Optic disc region crop.
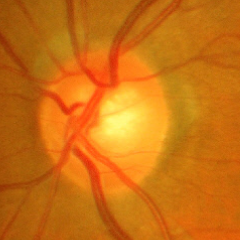

Findings consistent with glaucoma. Fundus image with findings of advanced glaucoma.